Phoenix ICON, 100° FOV. Pediatric wide-field fundus photograph. 1240x1240px: 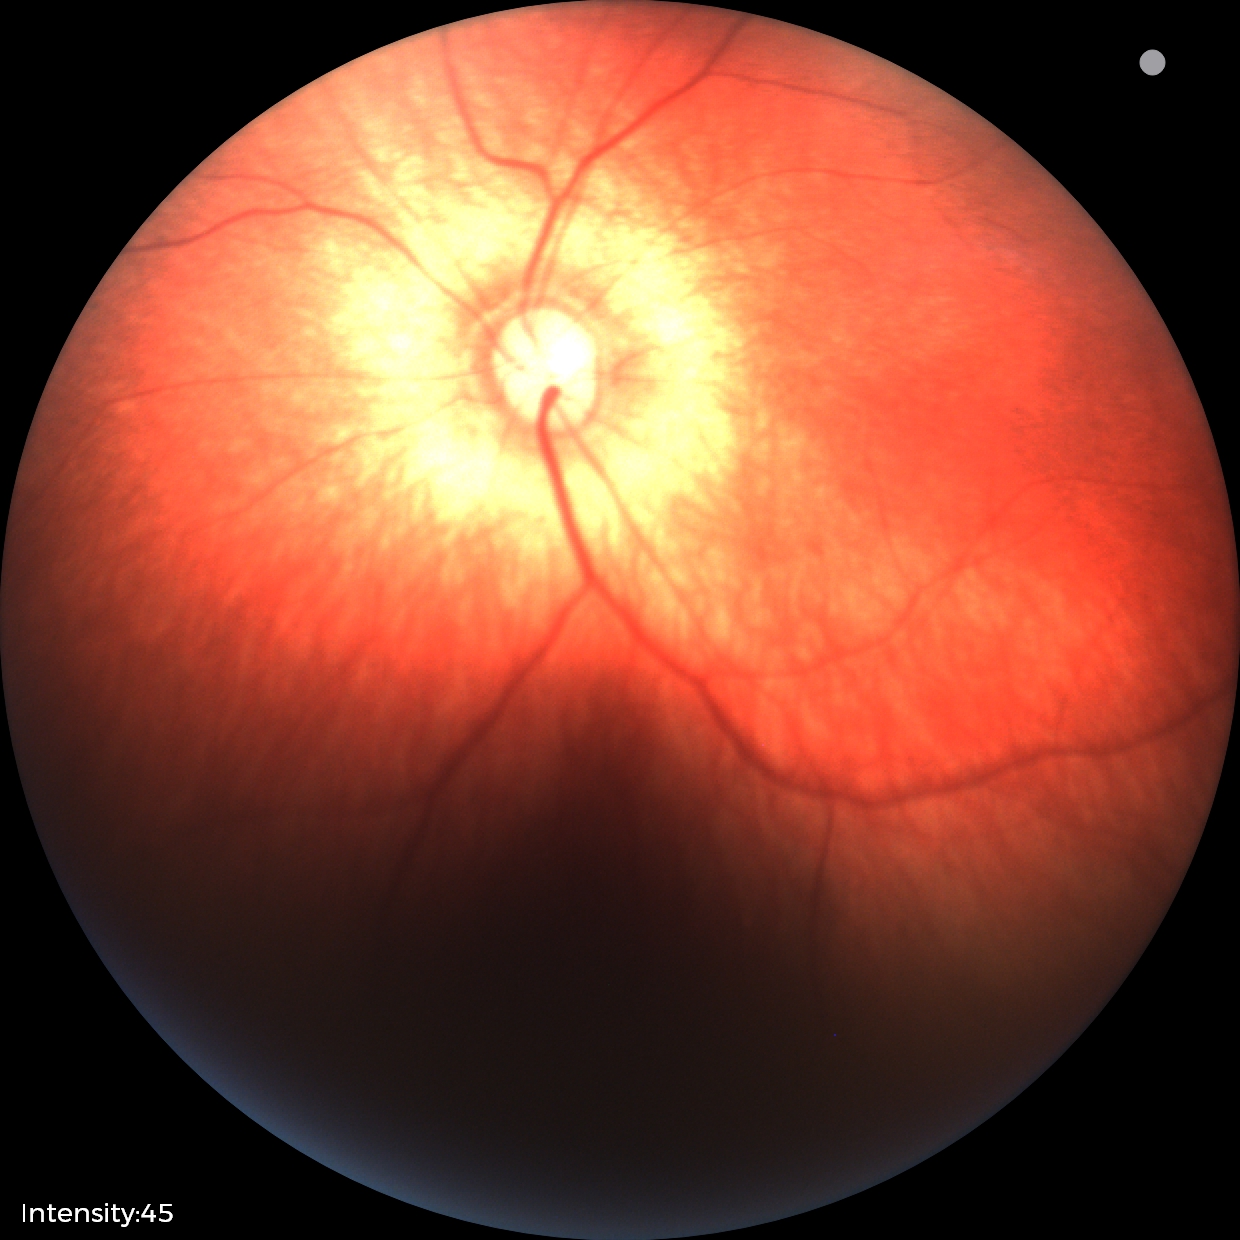

No retinal pathology identified on screening.